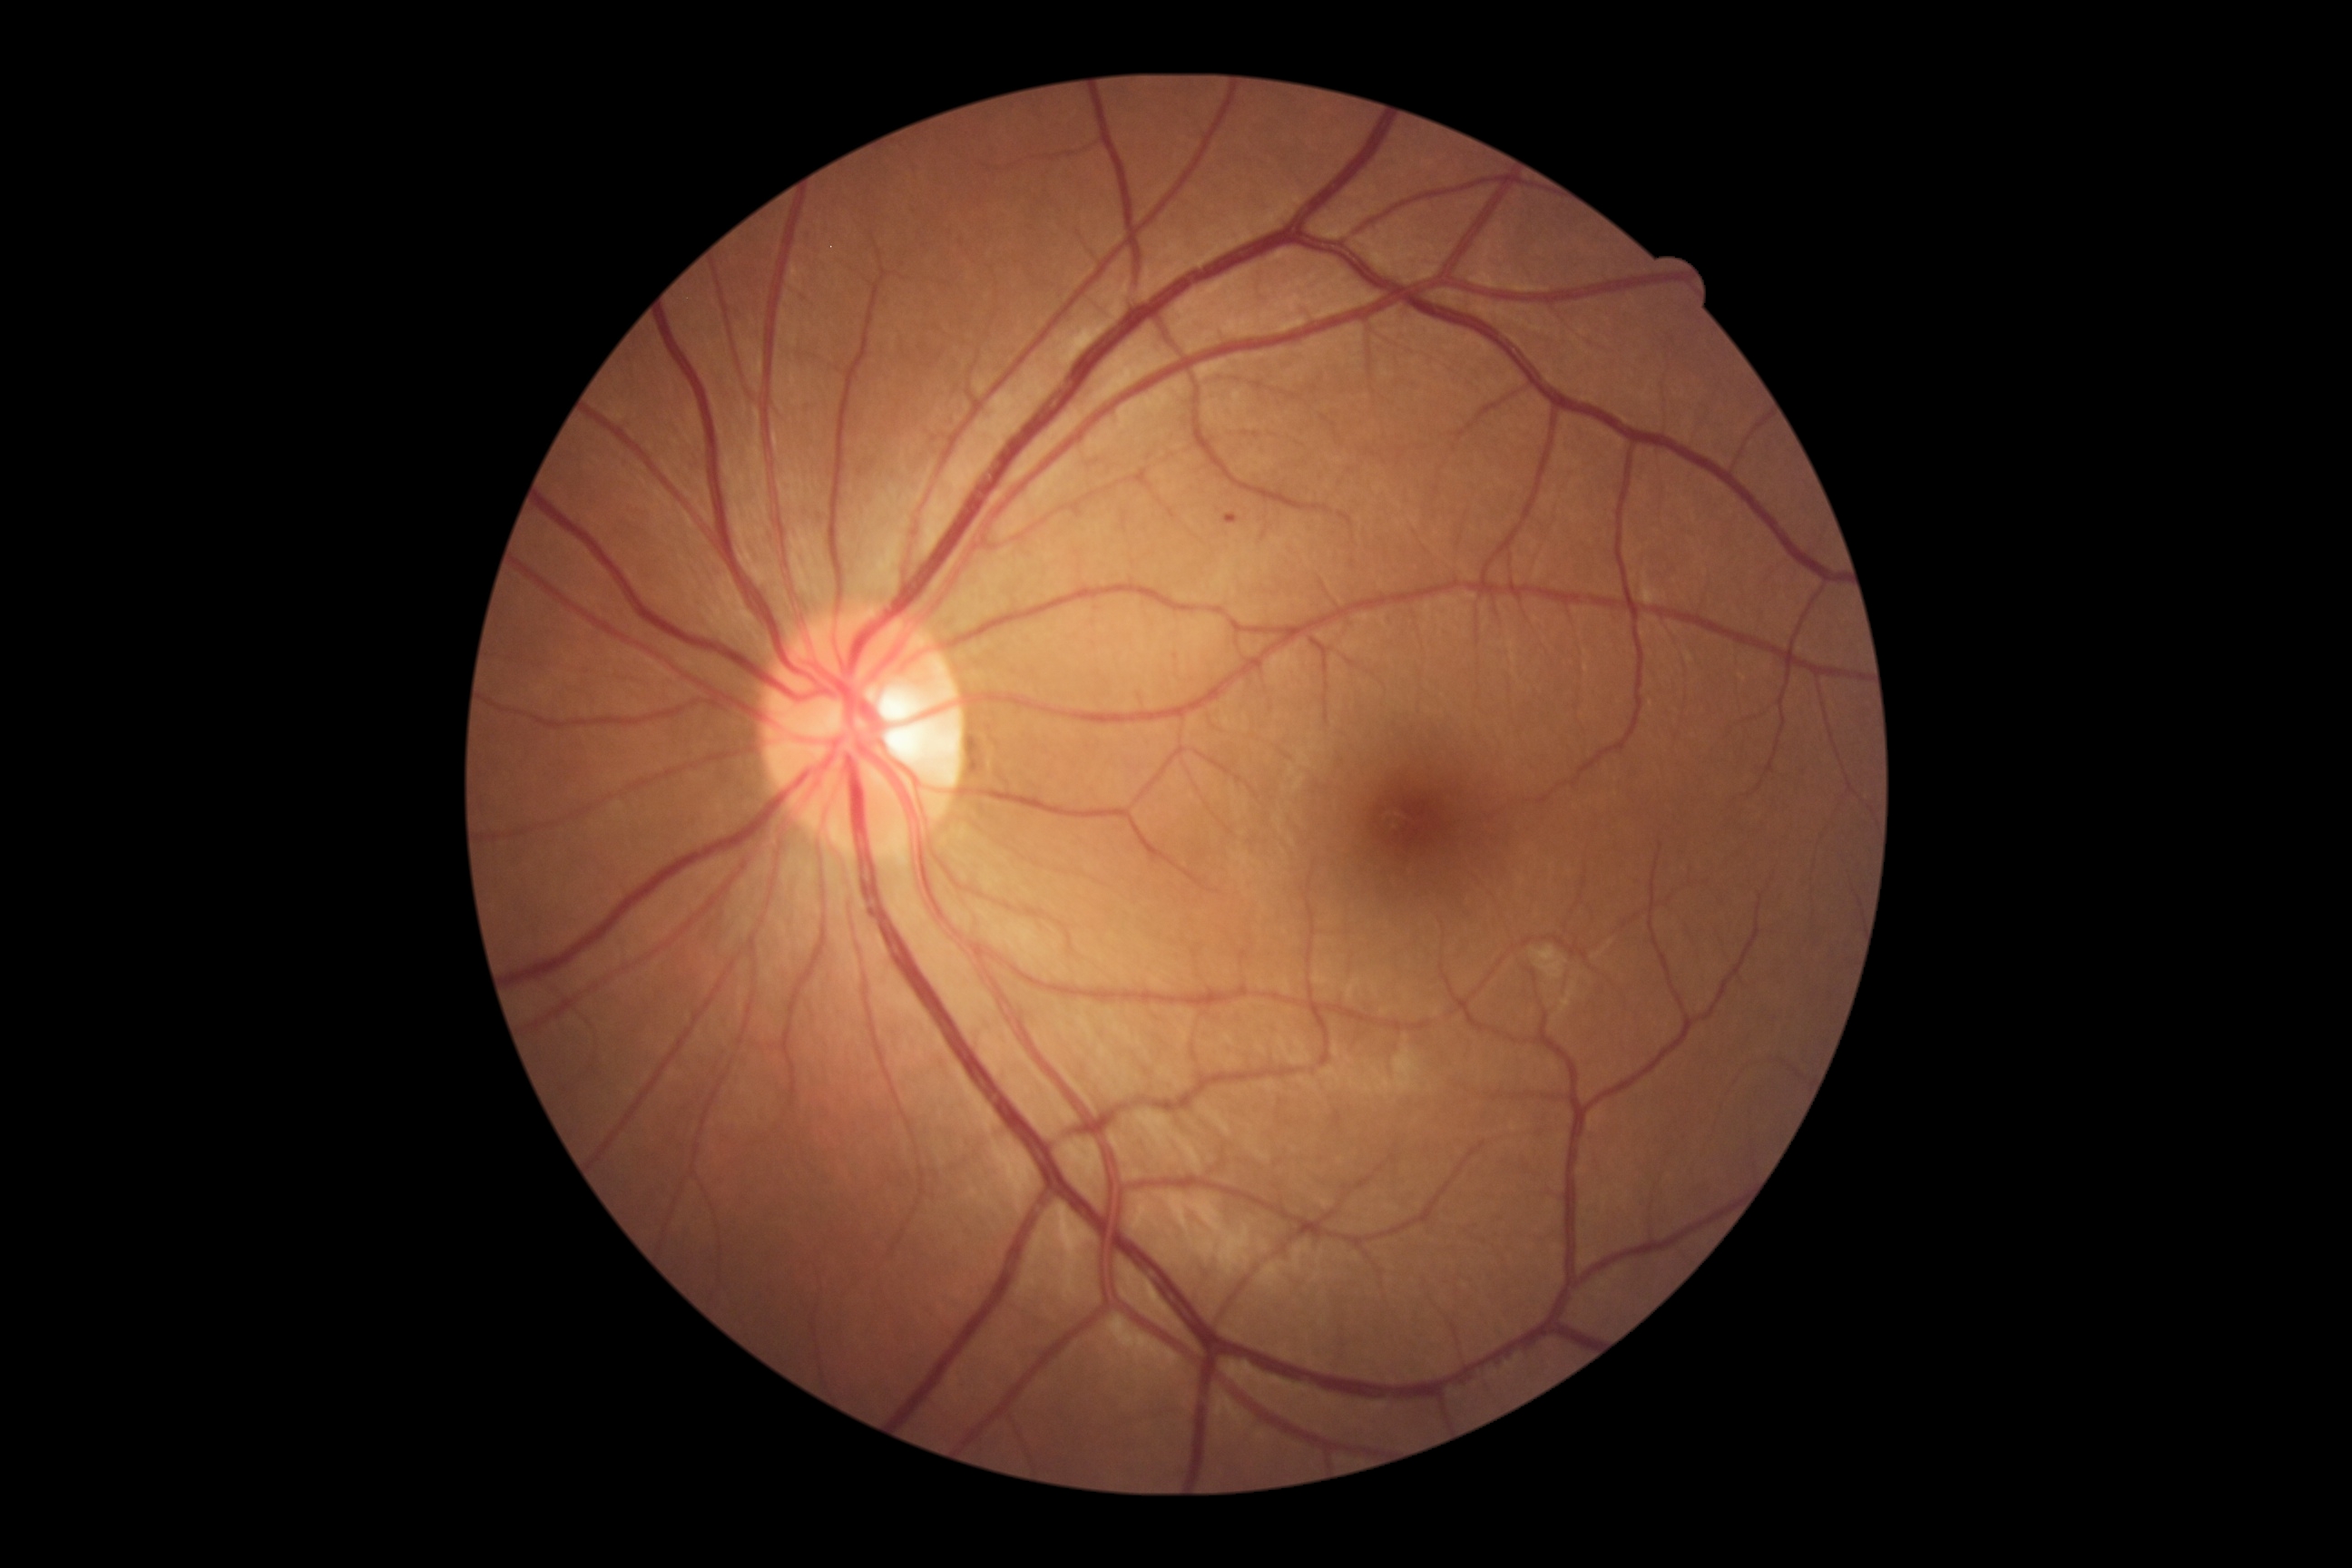

dr_grade: 1
lesions:
  se: []
  ex: []
  ma:
    - region(1230, 518, 1239, 525)
  he: []